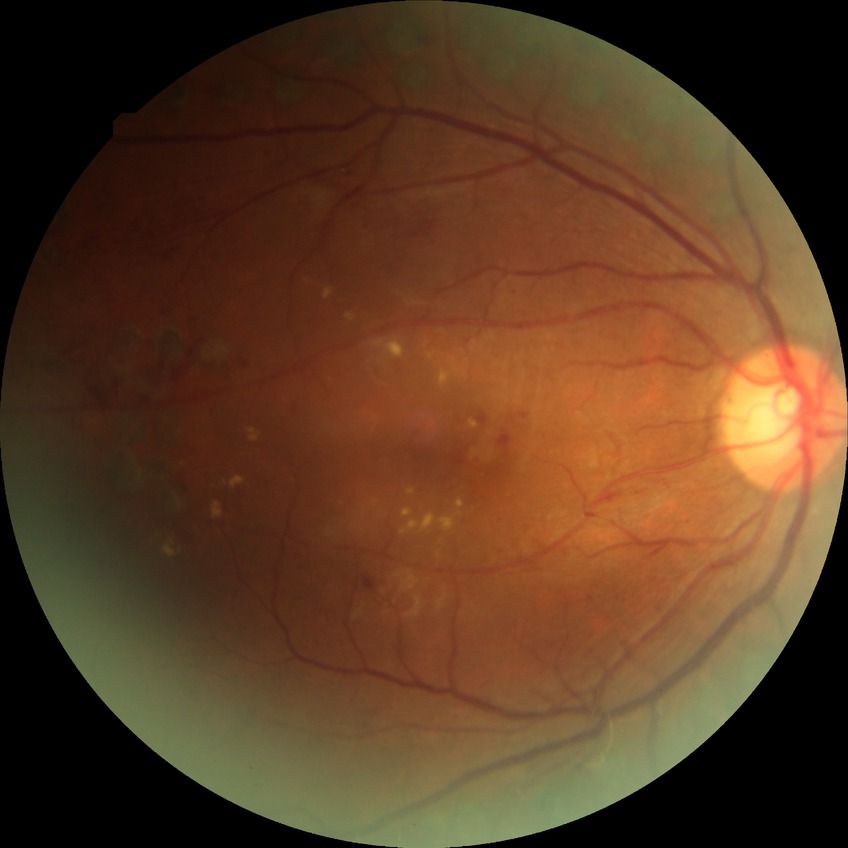

Diabetic retinopathy (DR) is proliferative diabetic retinopathy (PDR).